1932x1923. FOV: 45 degrees: 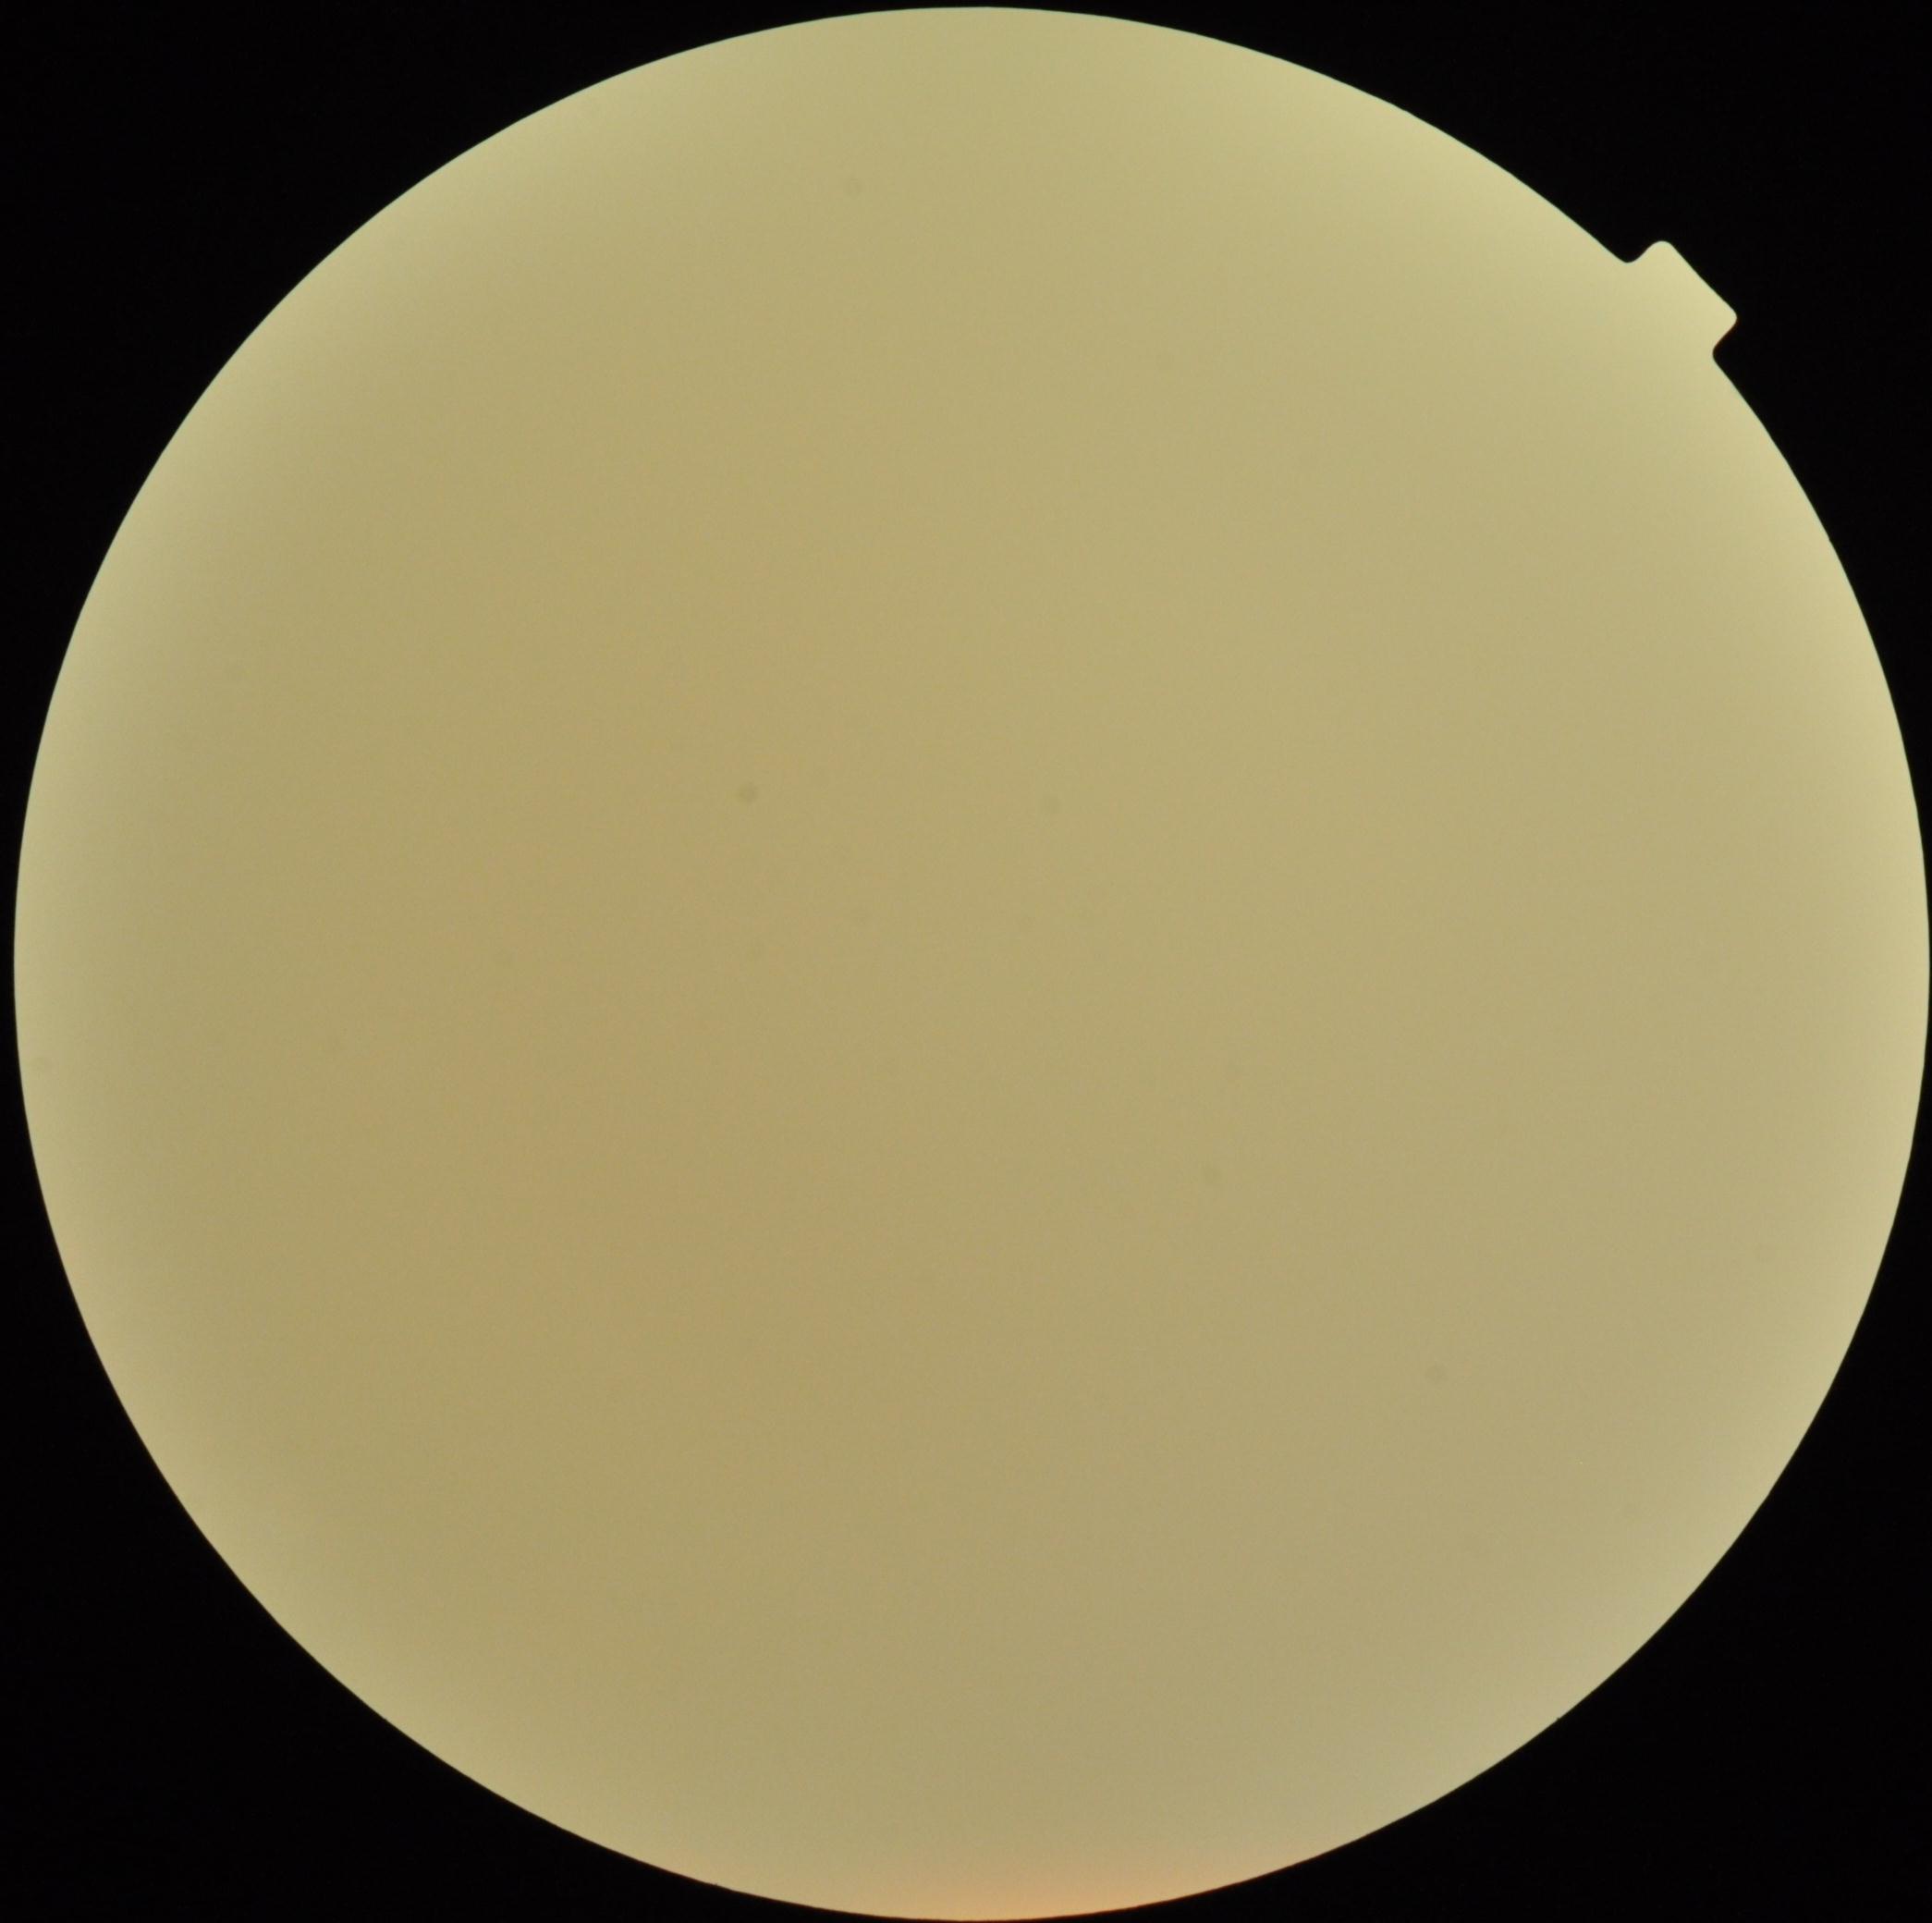

* image quality — insufficient for DR assessment
* diabetic retinopathy severity — ungradable due to poor image quality